Retinal fundus photograph
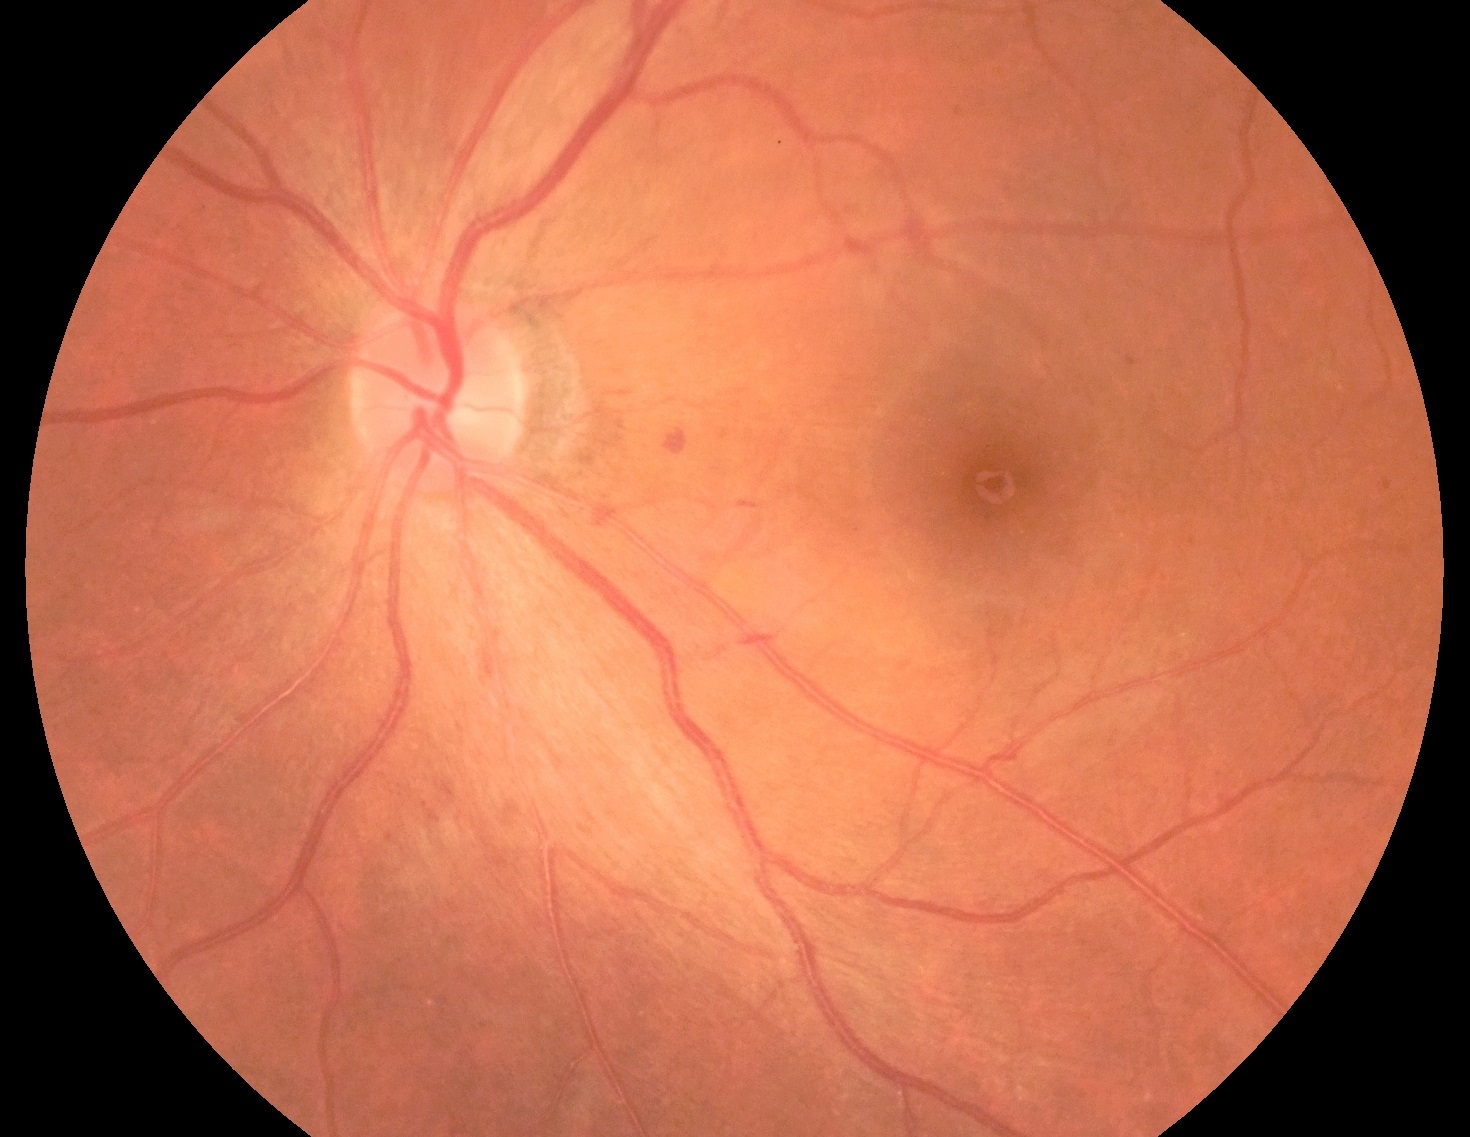

DR@2/4 — more than just microaneurysms but less than severe NPDR.